Color fundus photograph from a handheld portable camera — 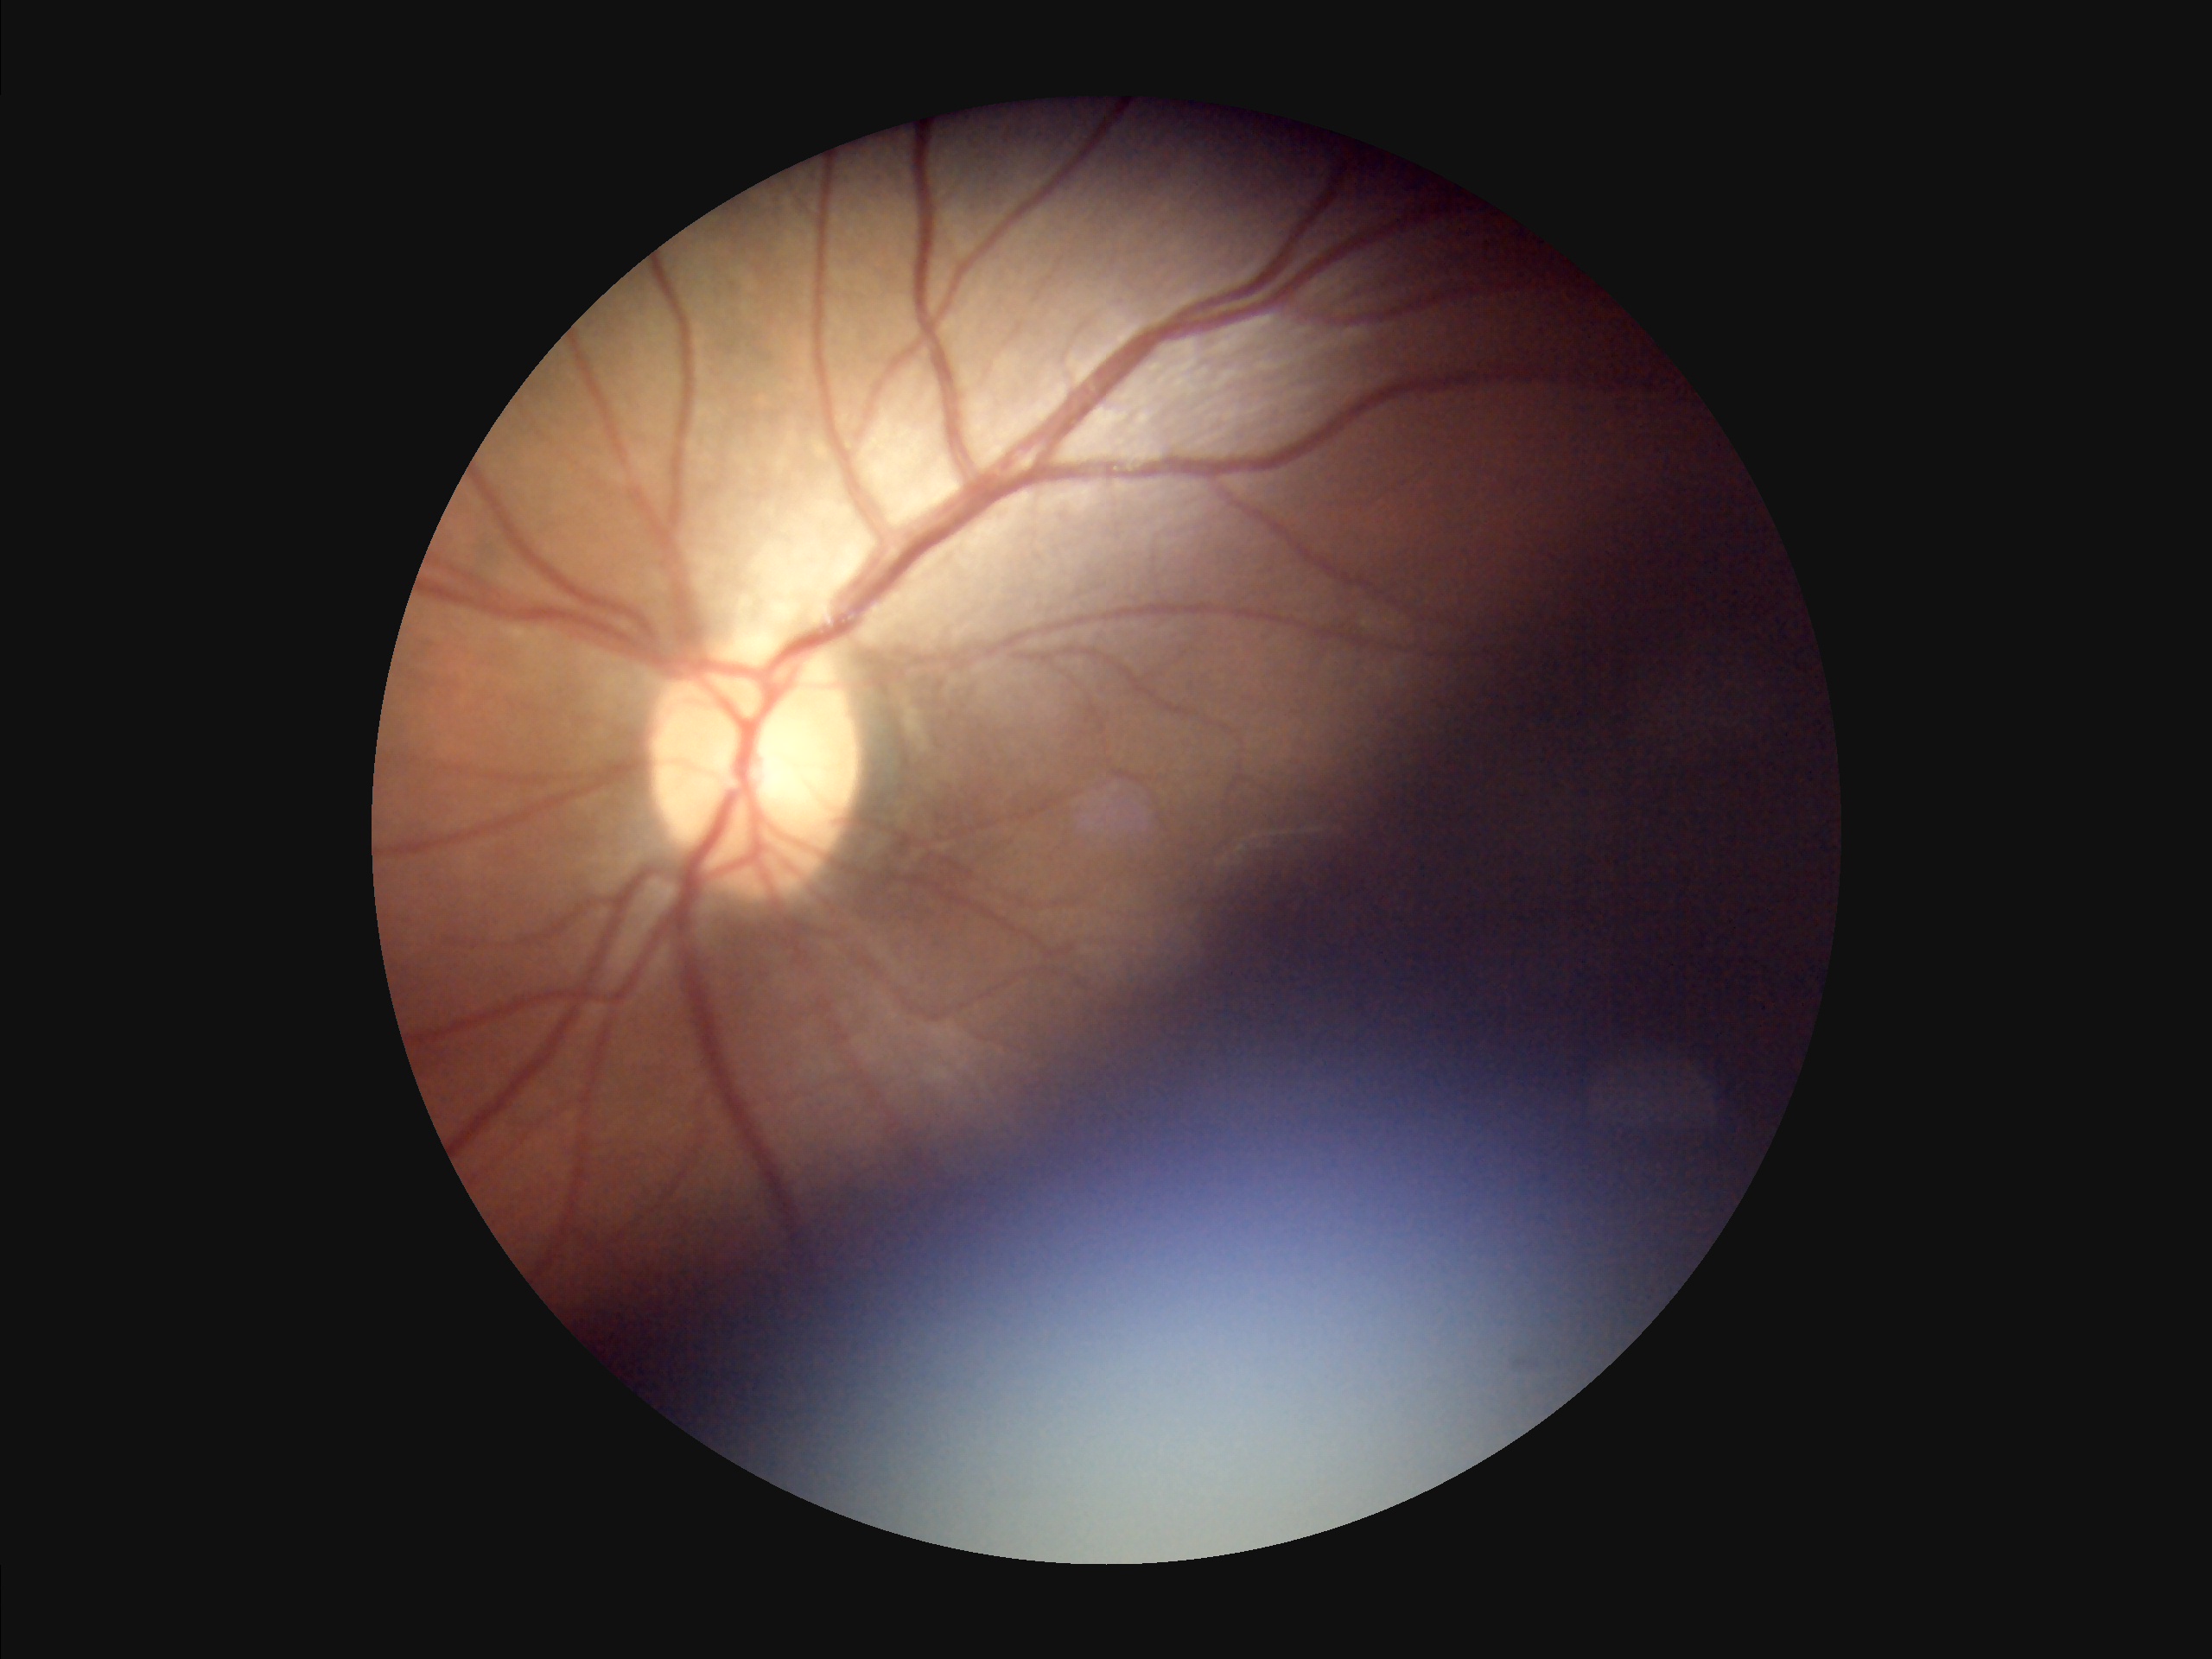

  clarity: poor
  illumination: suboptimal
  overall_quality: low
  contrast: good